45° field of view — 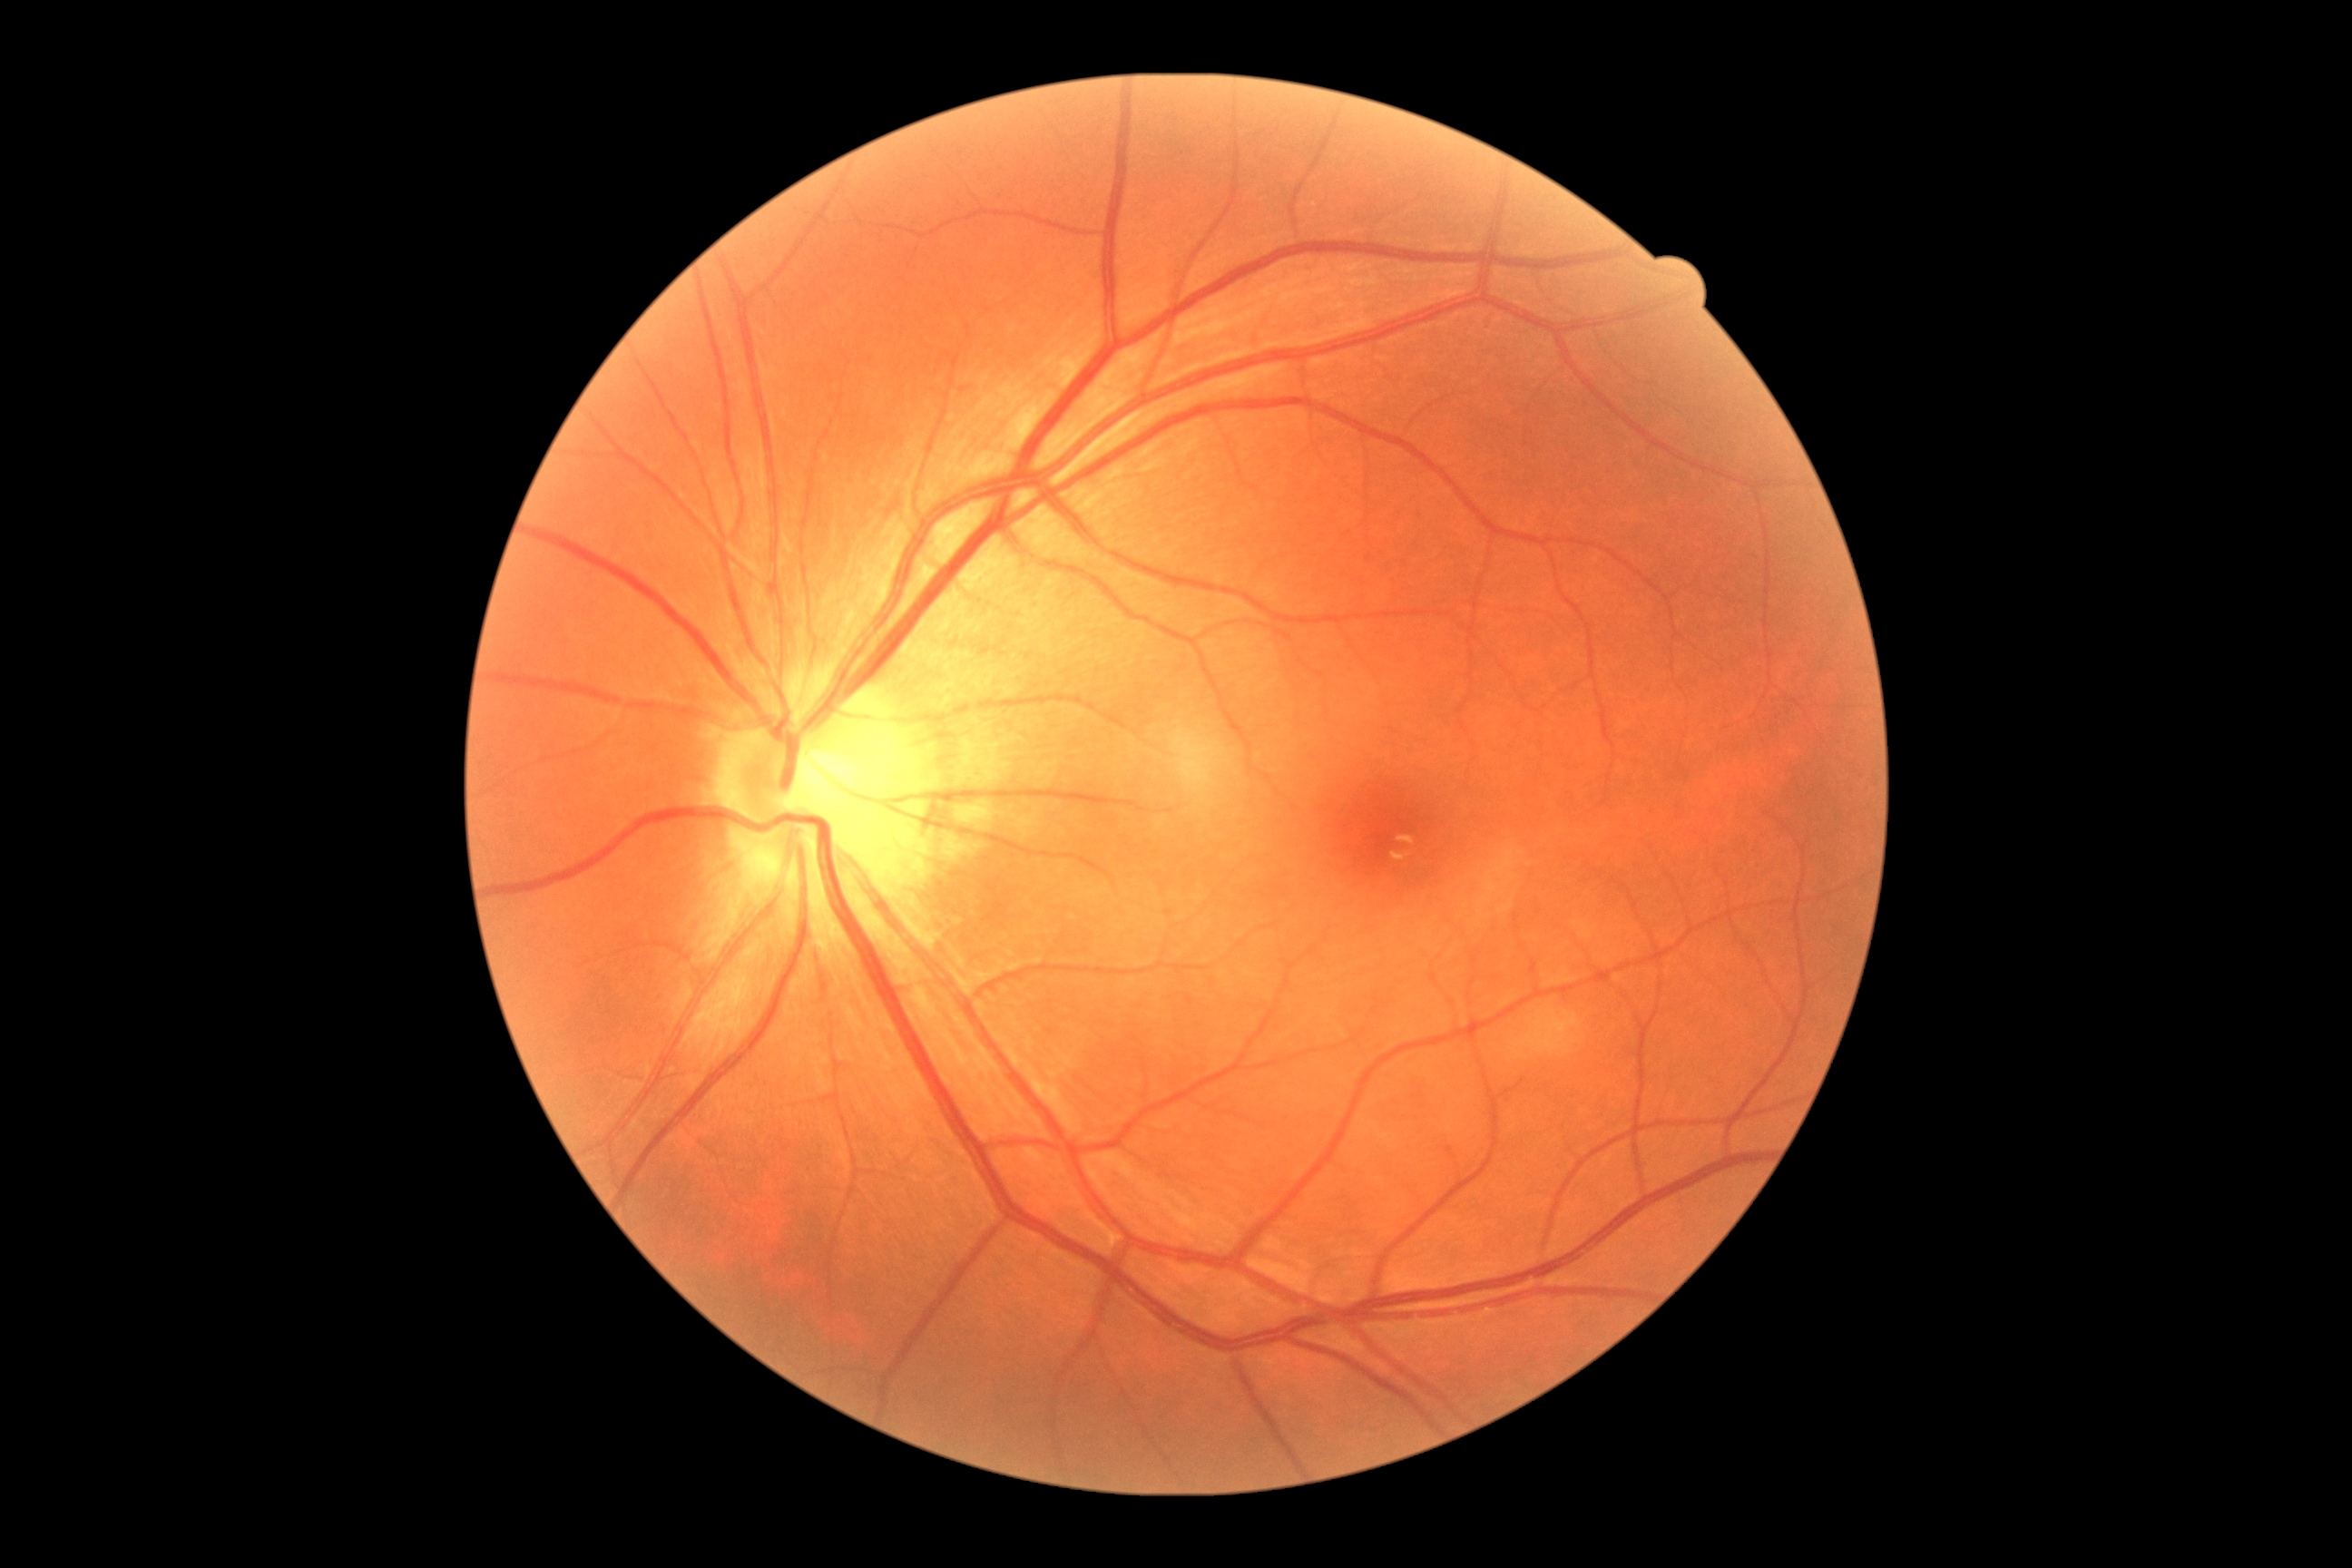
{"dr_grade": "no apparent retinopathy (grade 0)"}